Infant wide-field fundus photograph.
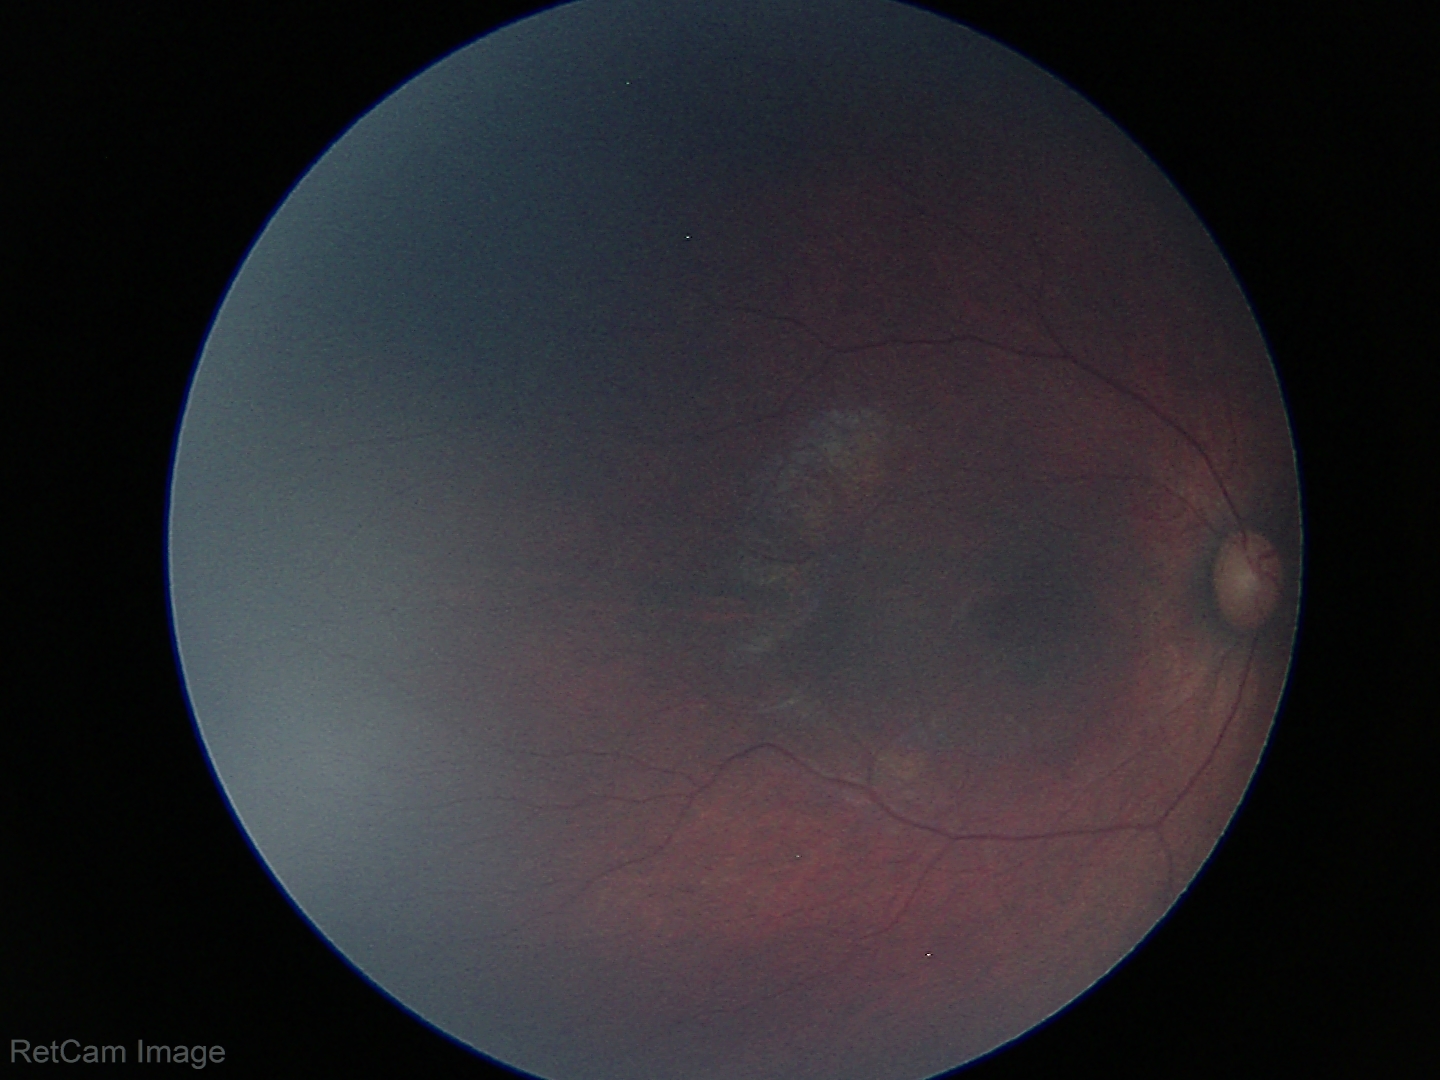

Physiological retinal appearance for postconceptual age.